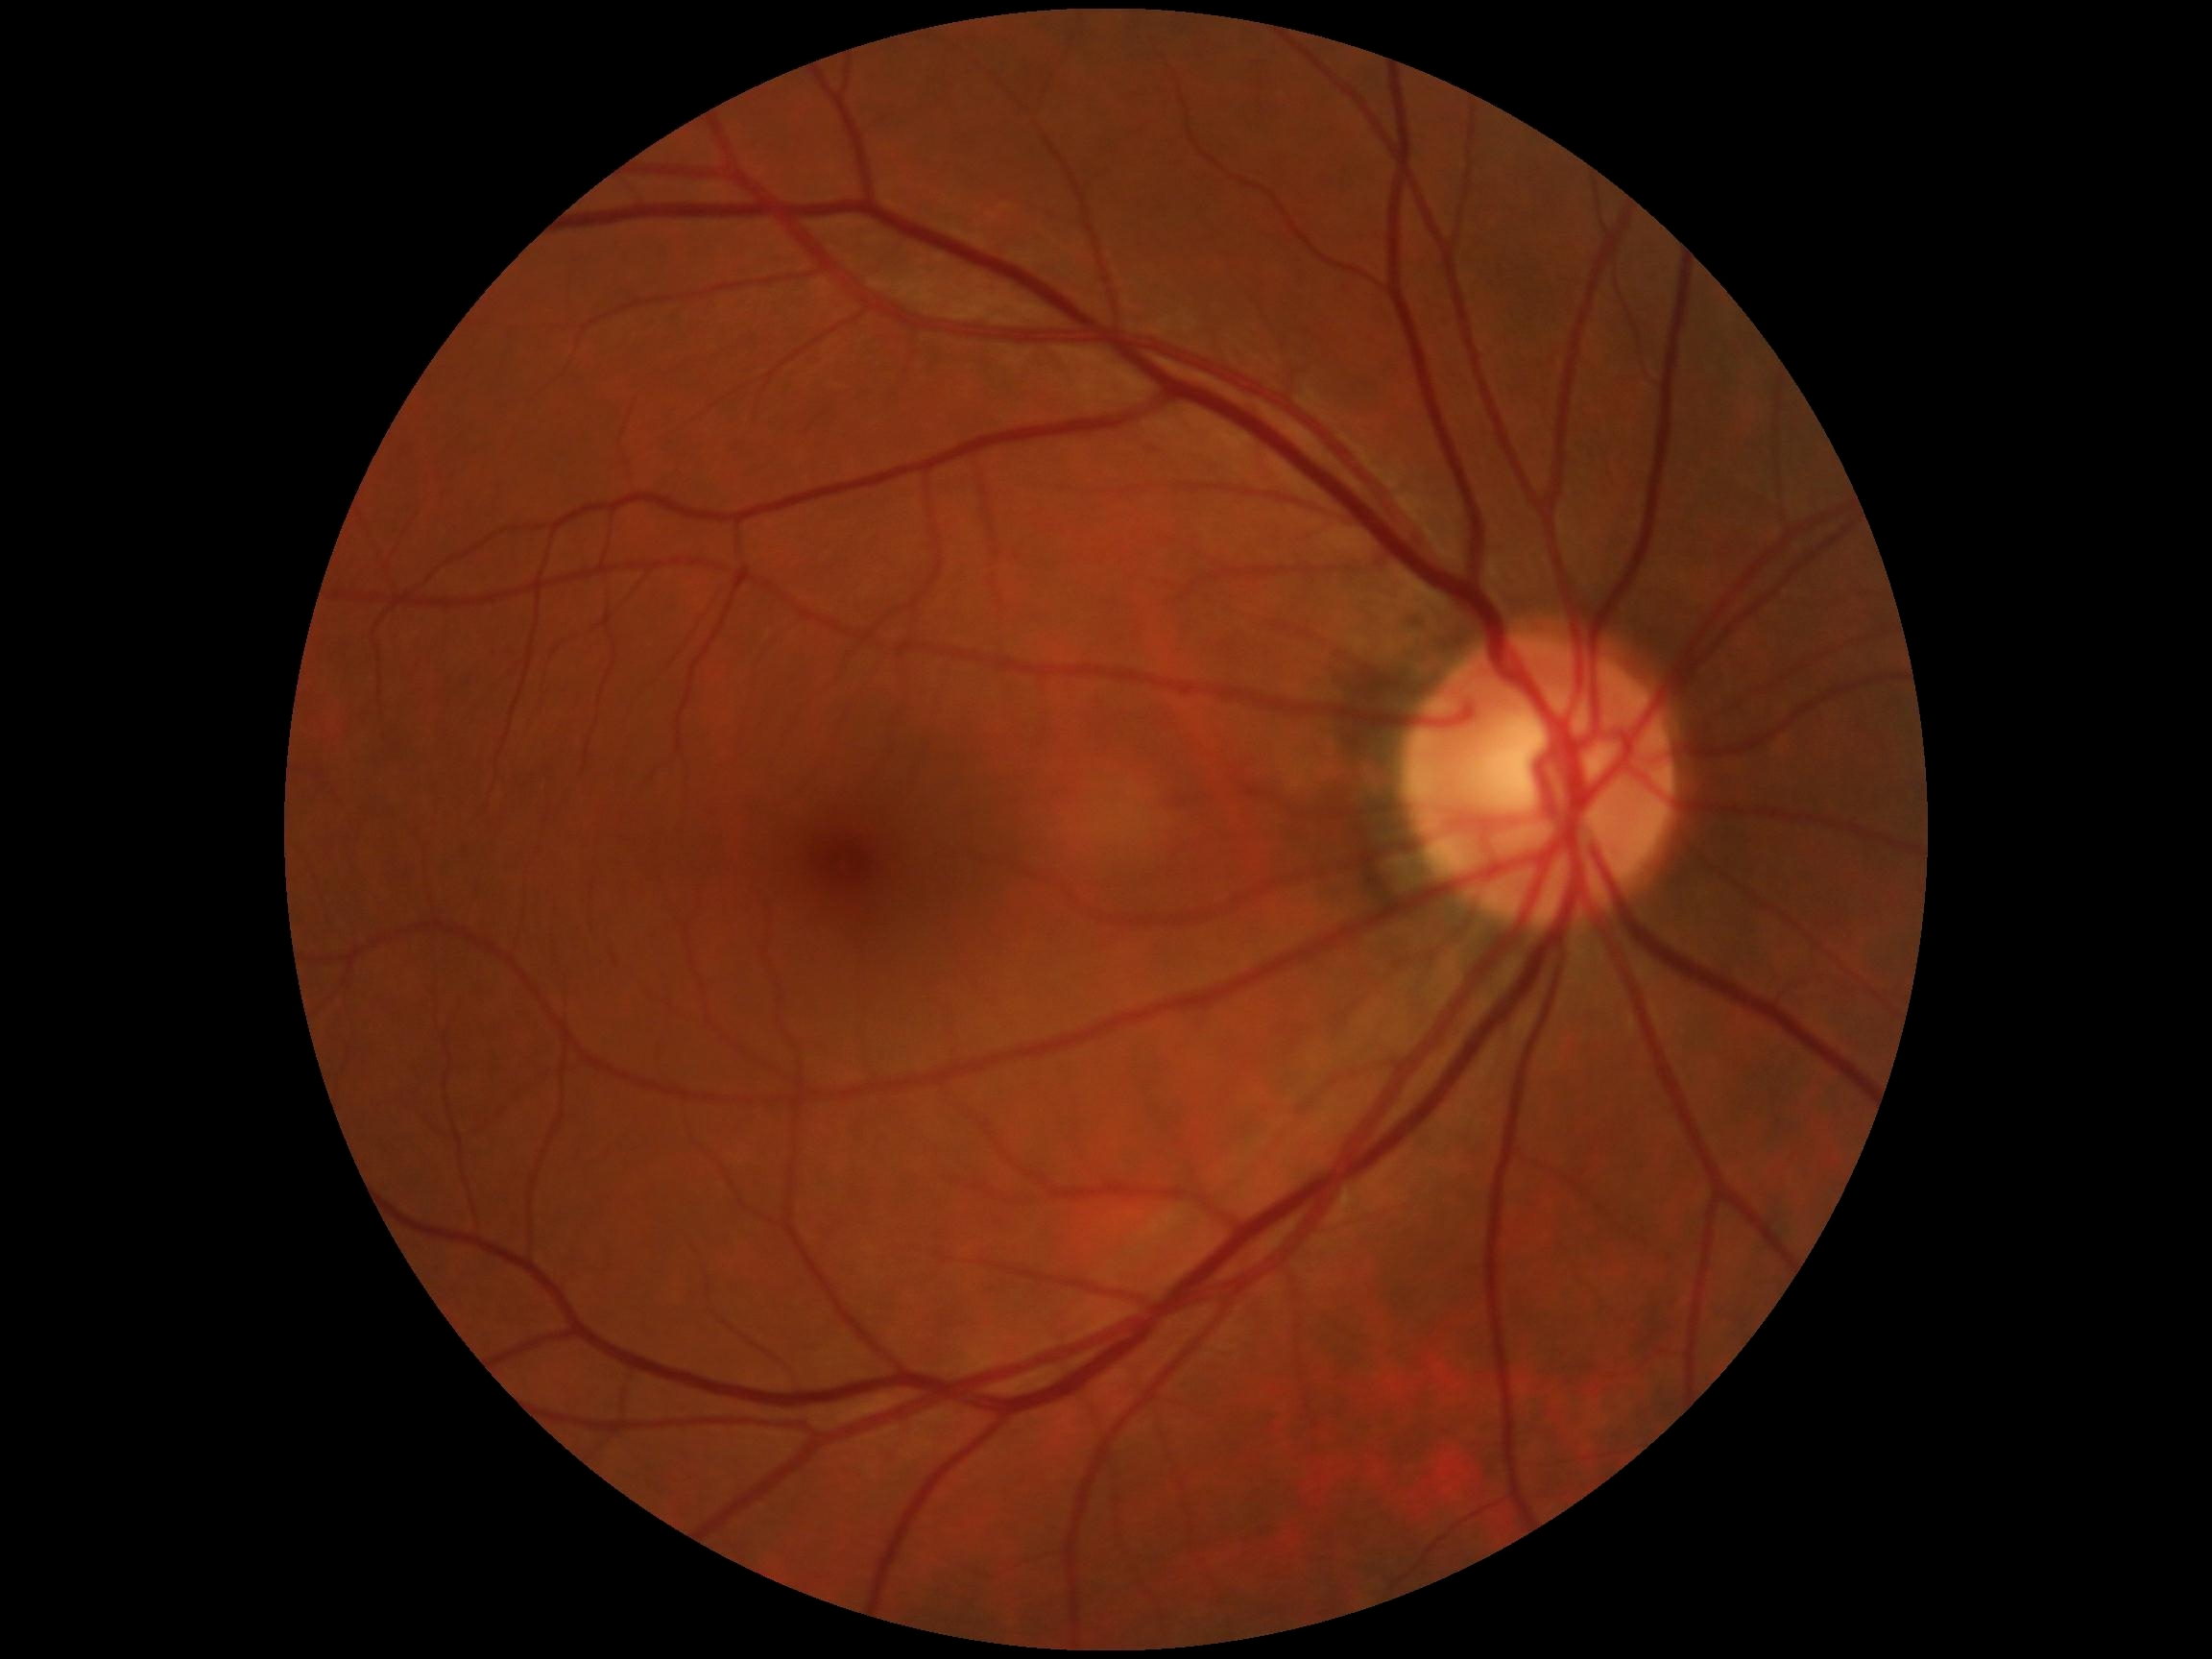

Diabetic retinopathy: grade 0 (no apparent retinopathy) — no visible signs of diabetic retinopathy.